Posterior pole view, captured after pupil dilation
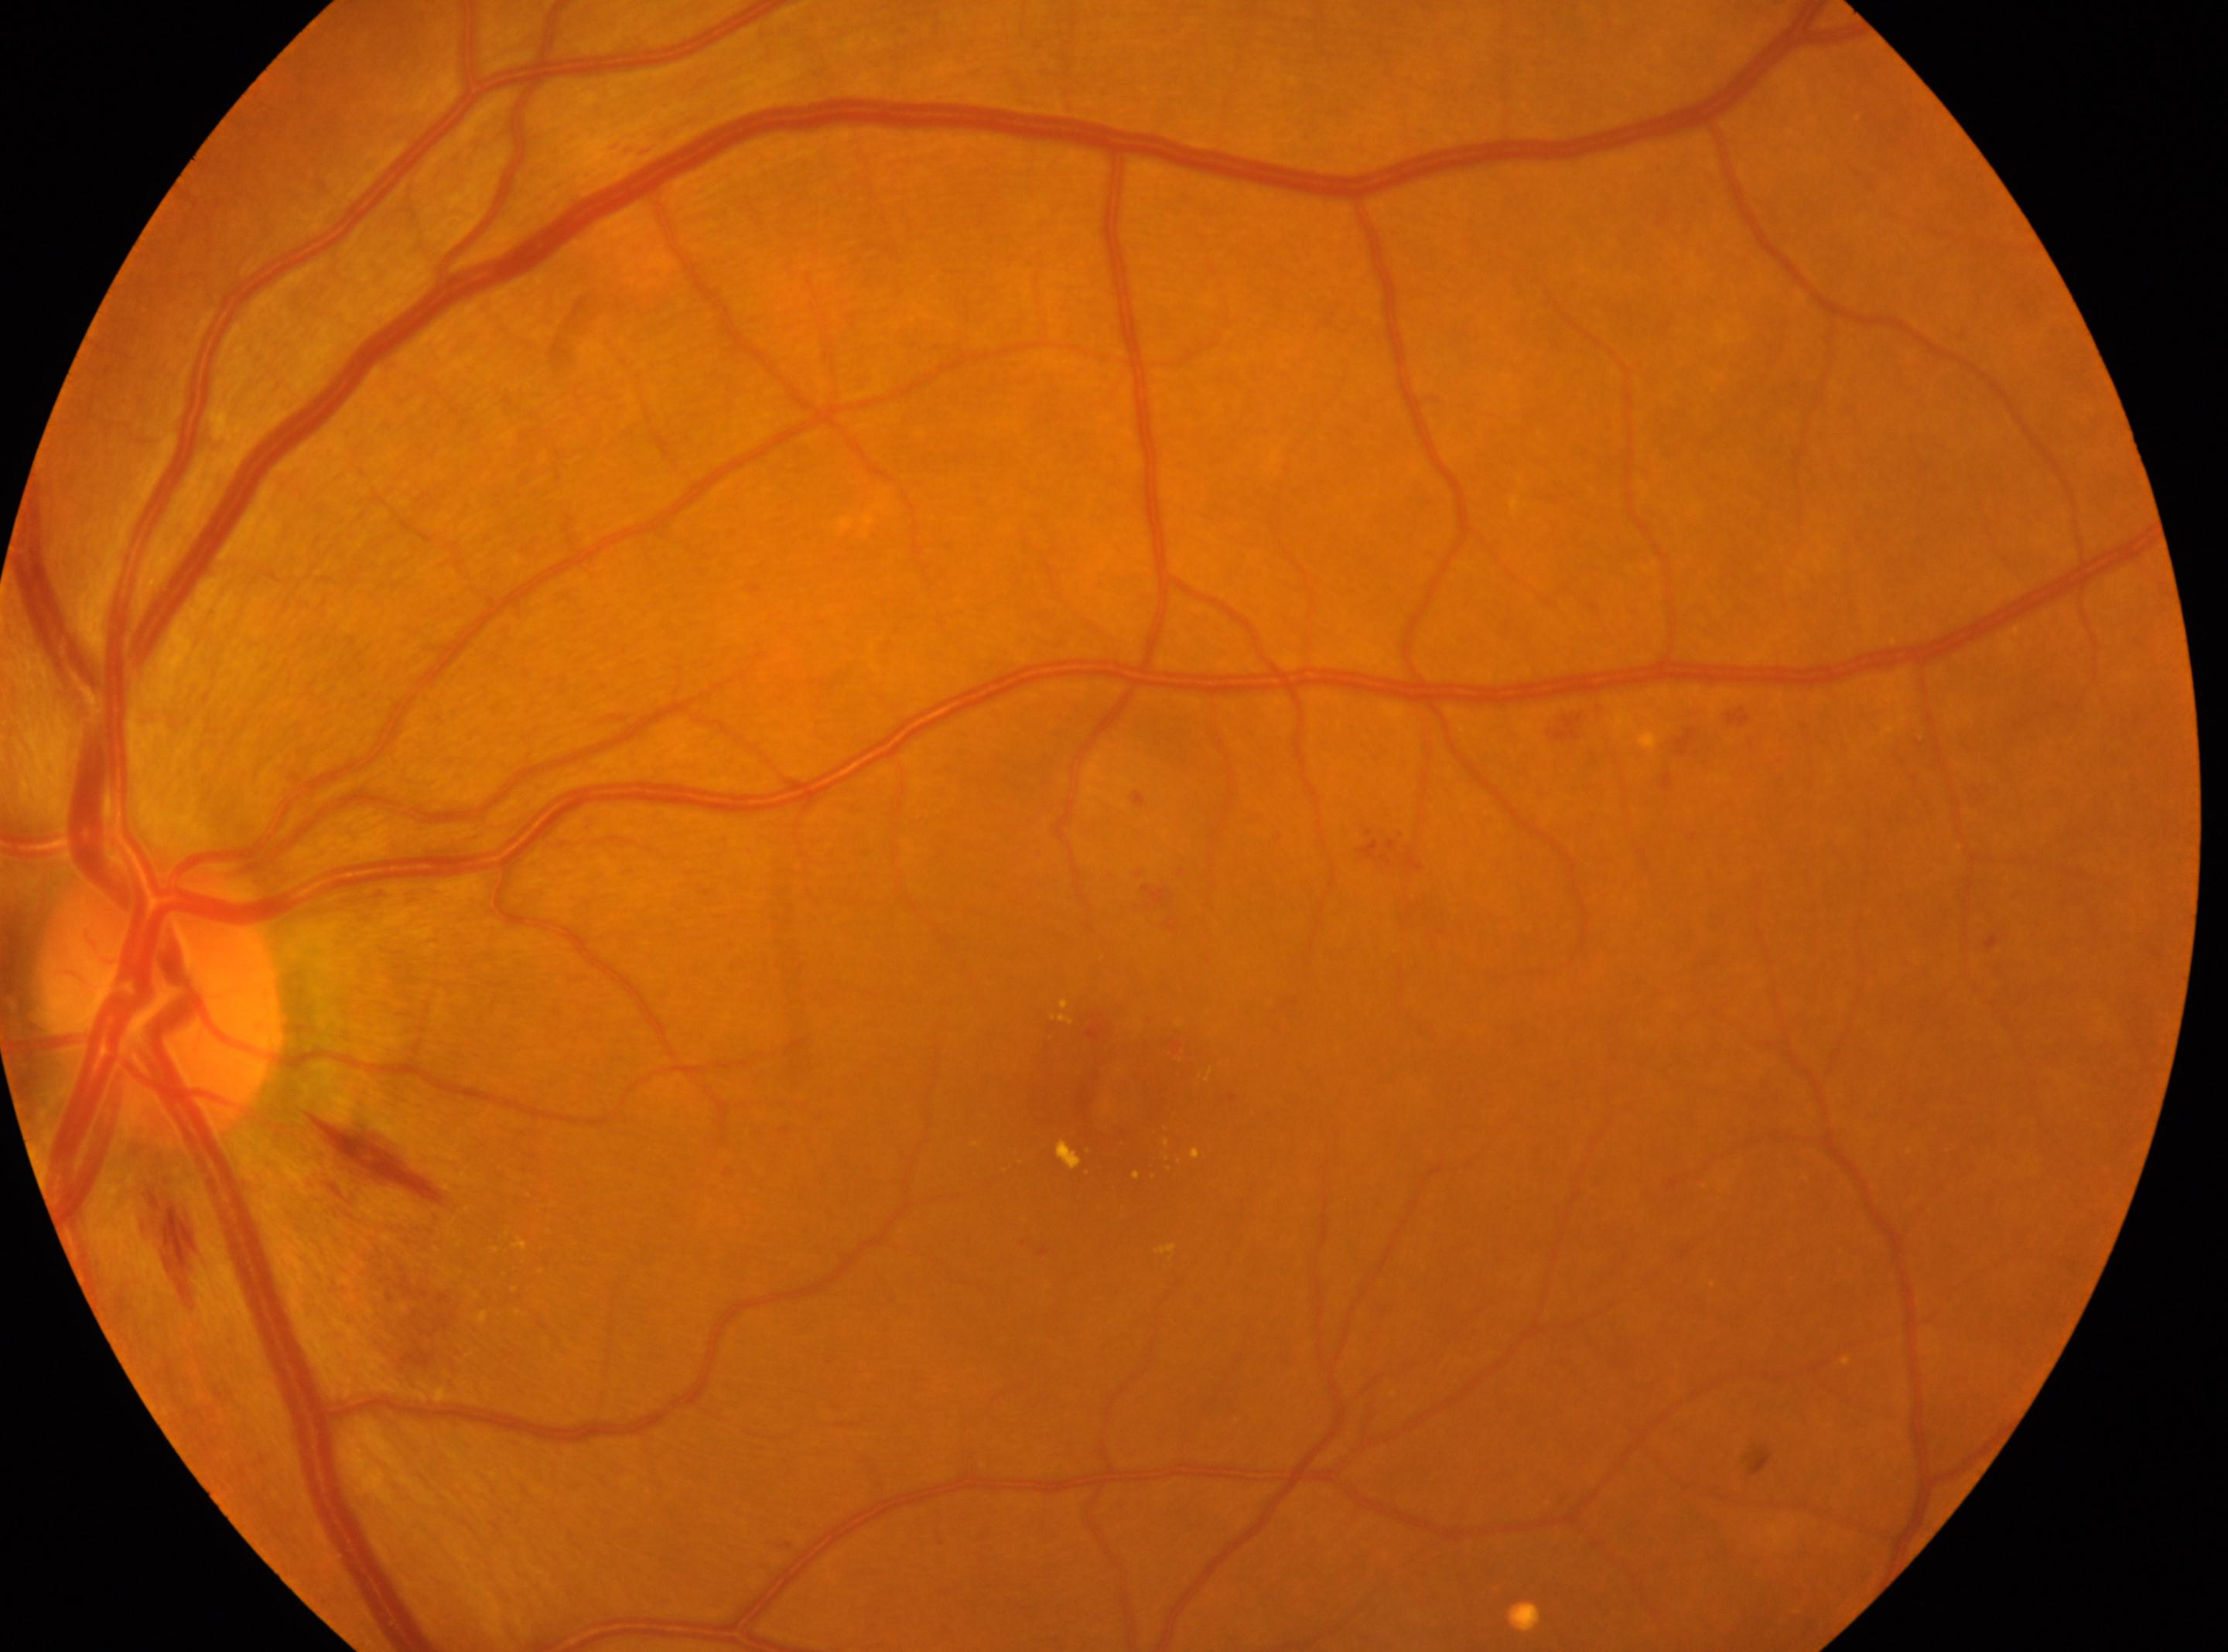
Annotations:
* fovea centralis · x=1108, y=1092
* optic nerve head · x=159, y=996
* DR class · non-proliferative diabetic retinopathy
* laterality · left eye
* diabetic retinopathy · moderate NPDR (grade 2) — more than just microaneurysms but less than severe NPDR